45-degree field of view — 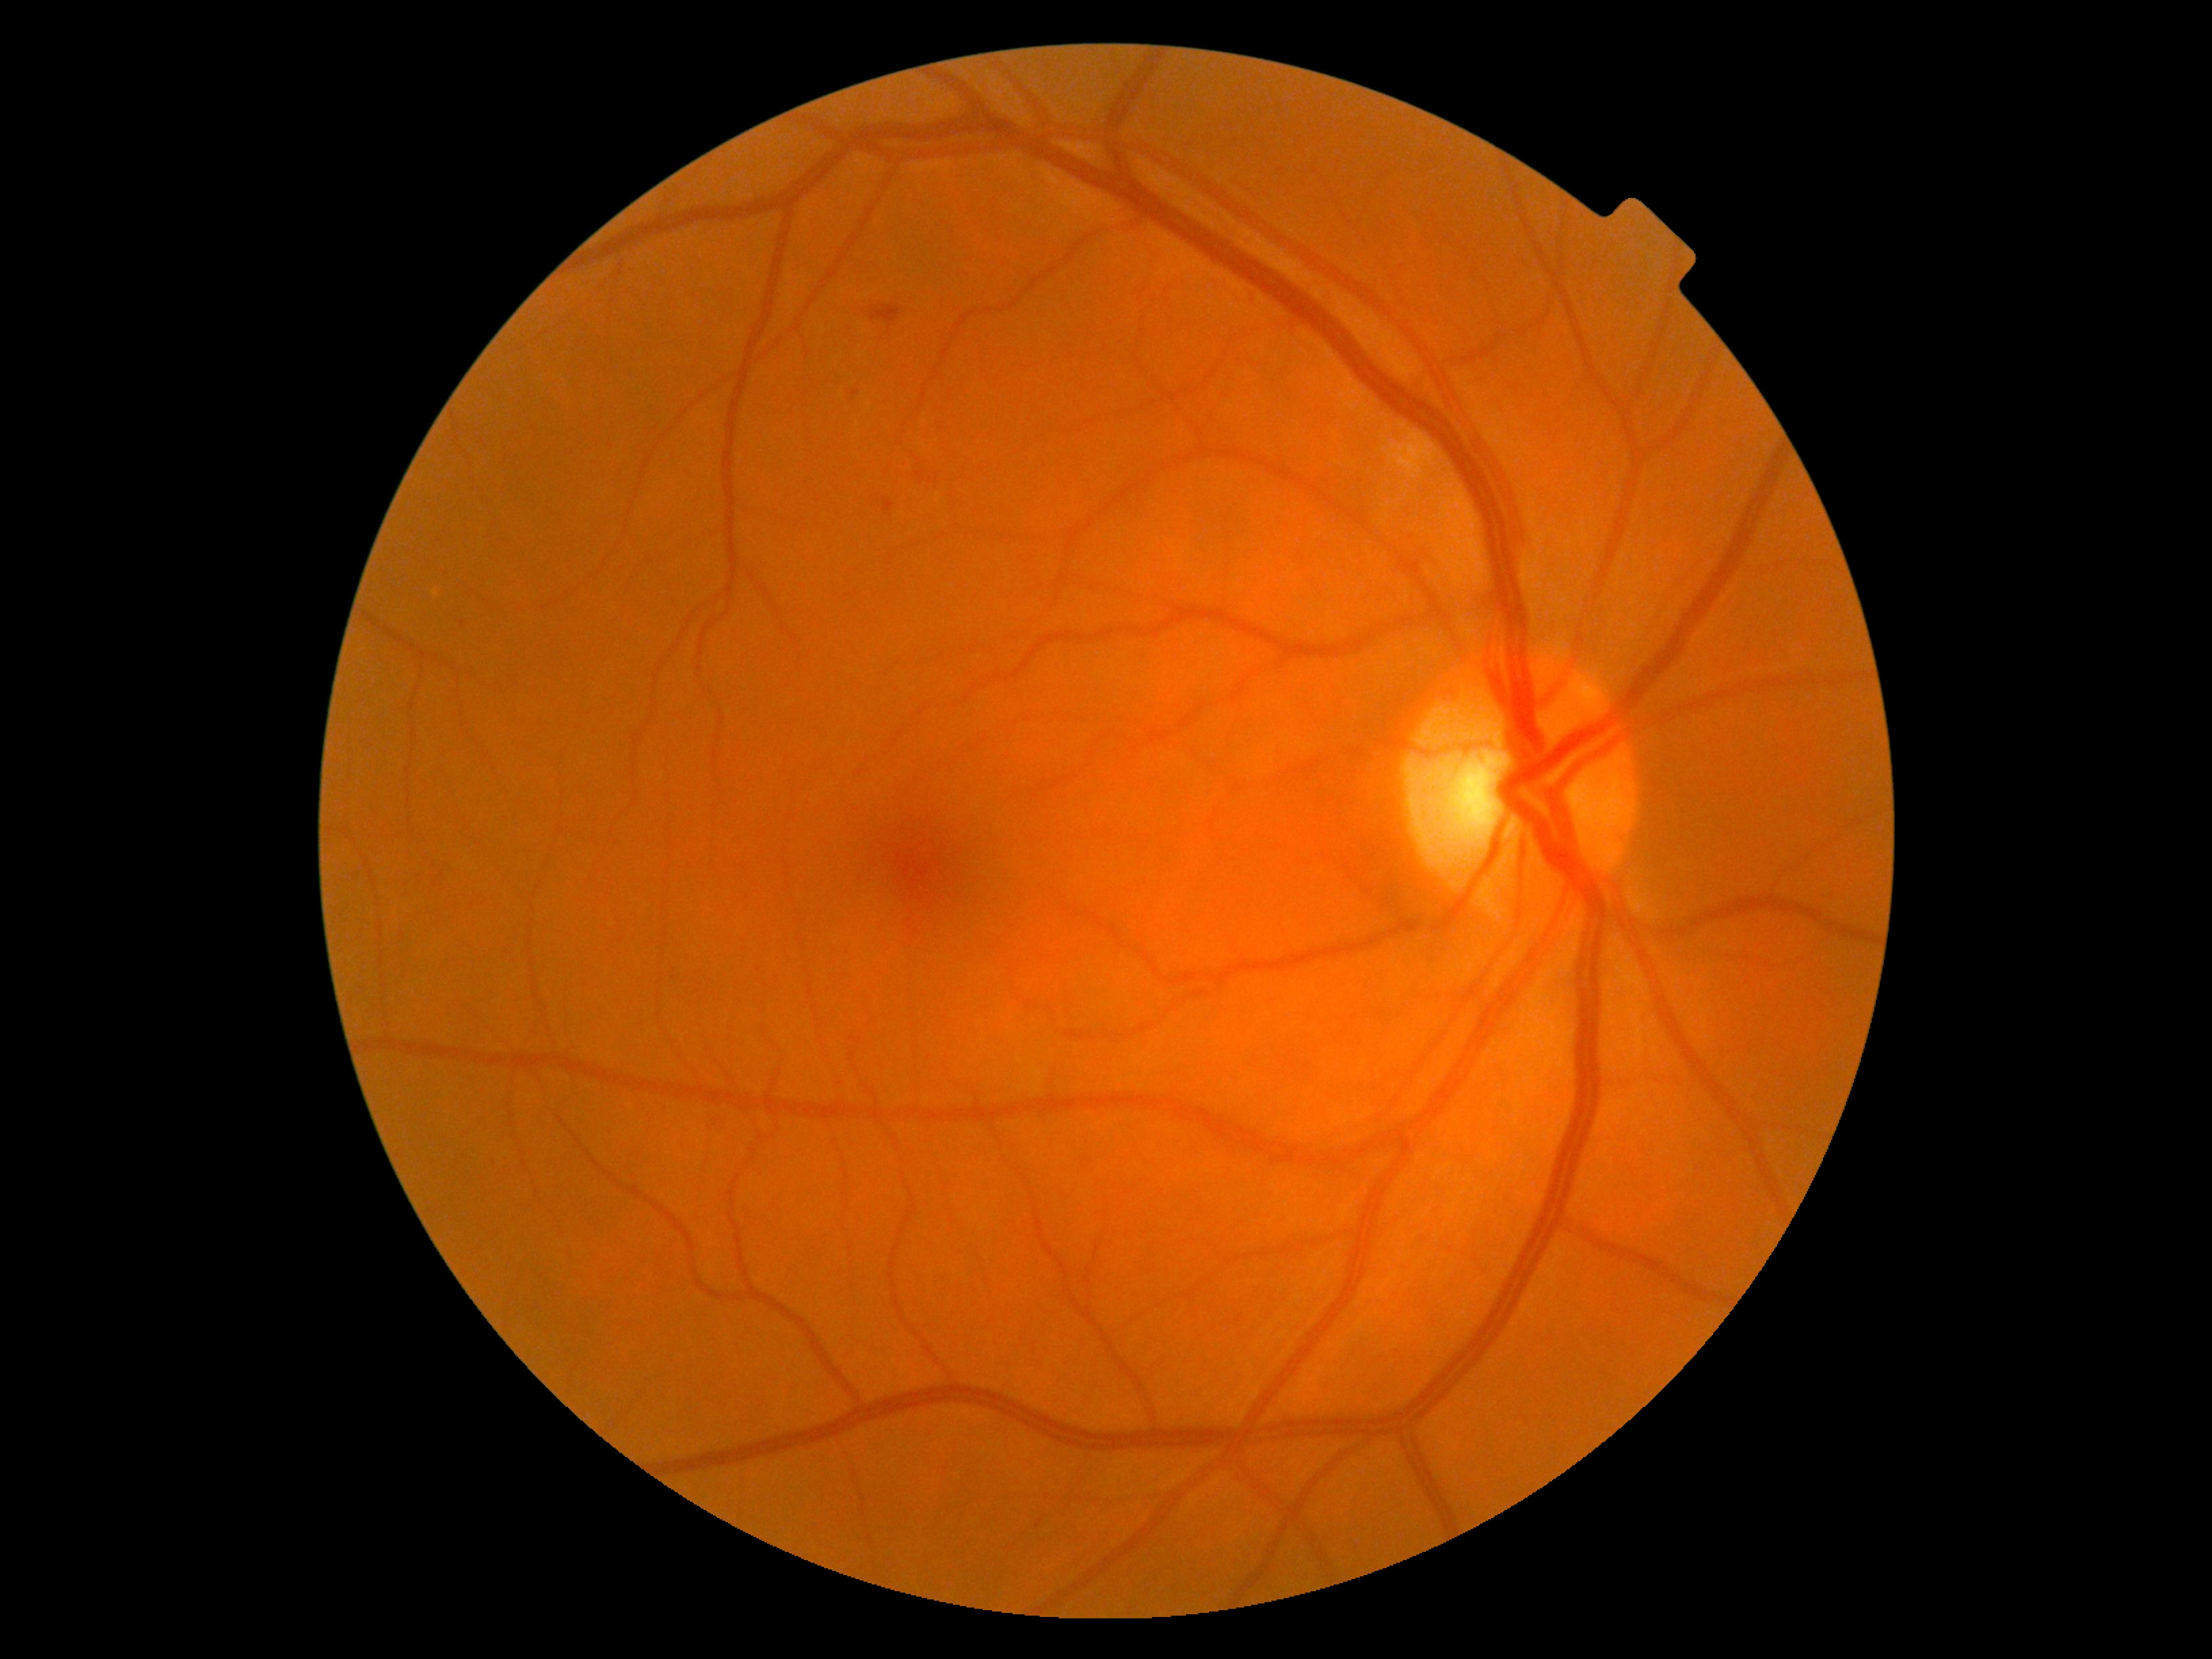

Diabetic retinopathy (DR): grade 2 (moderate NPDR).